Image size 2352x1568: 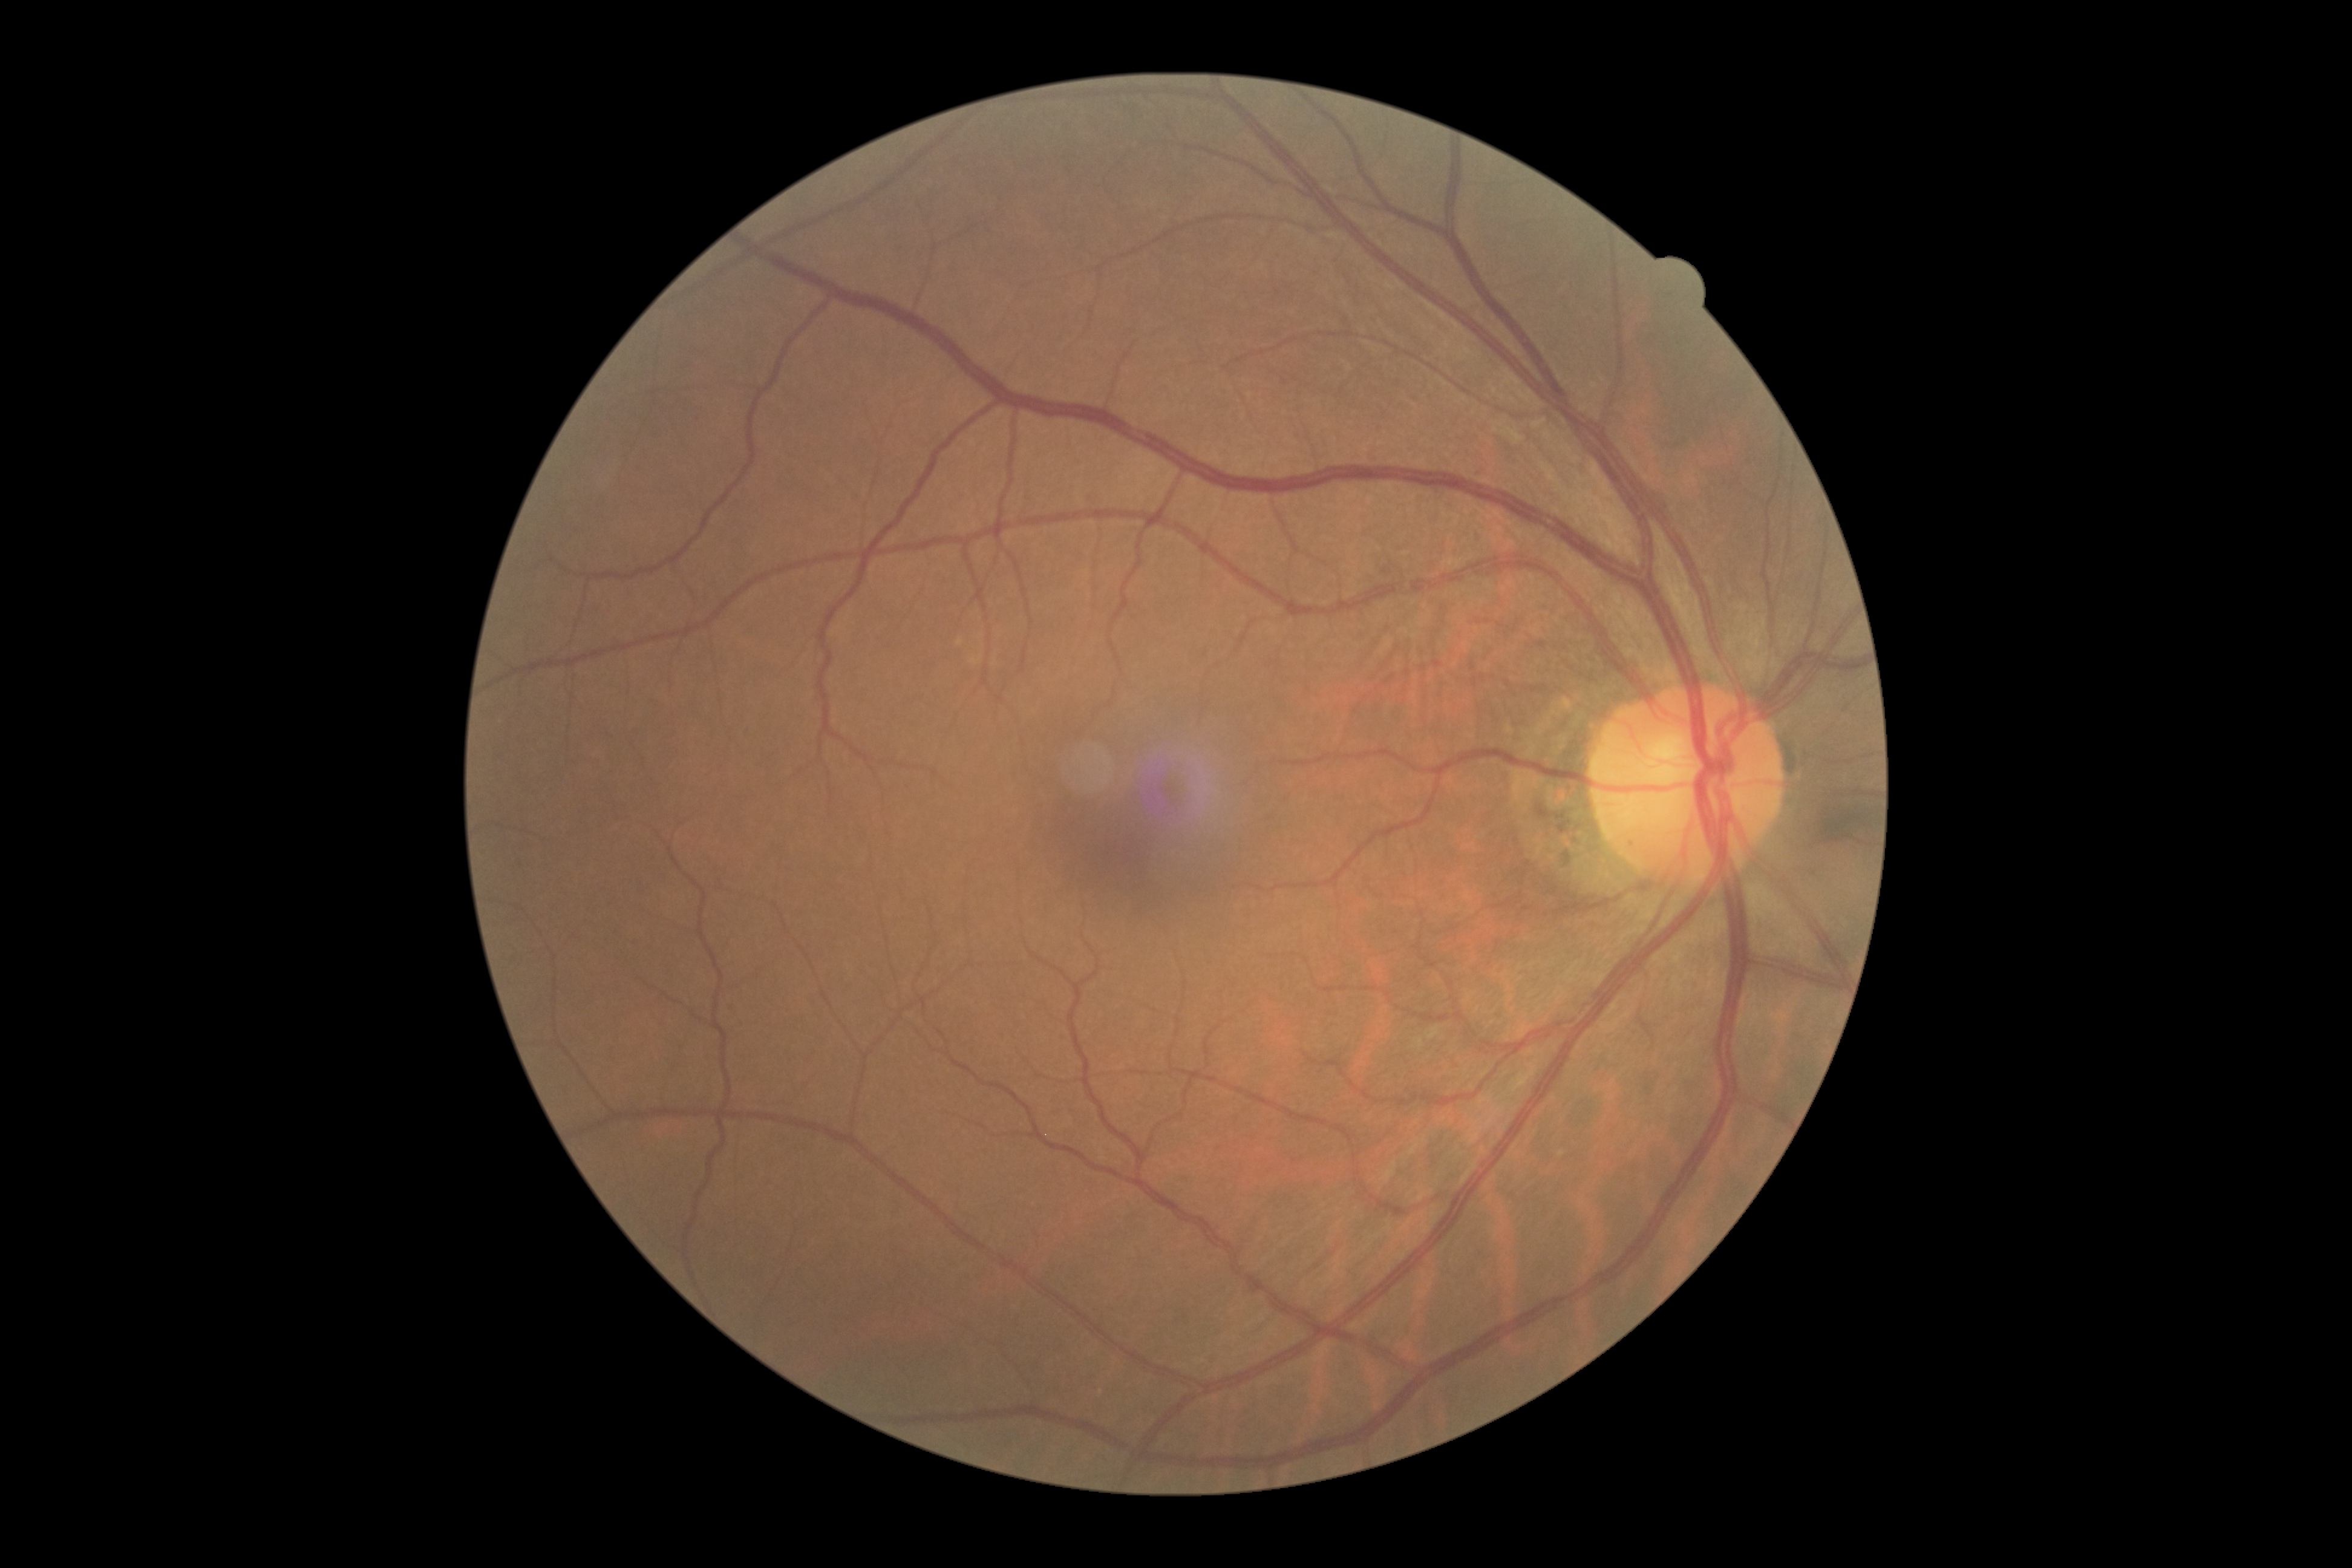 DR impression: negative for DR; DR severity: 0/4.